640 by 480 pixels; 130° field of view (Clarity RetCam 3); infant wide-field fundus photograph: 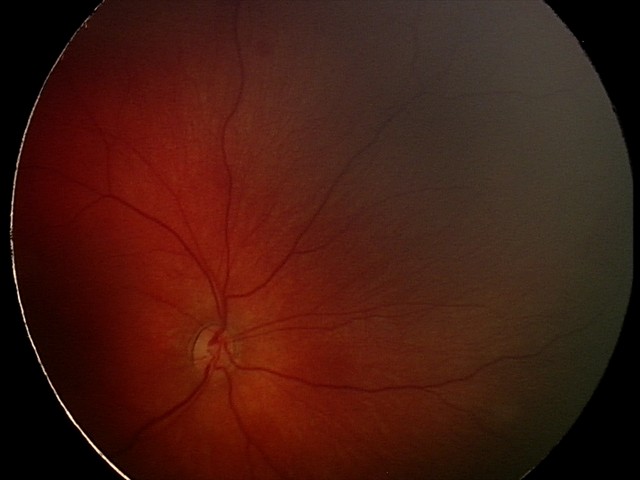 Assessment: retinal hemorrhages.